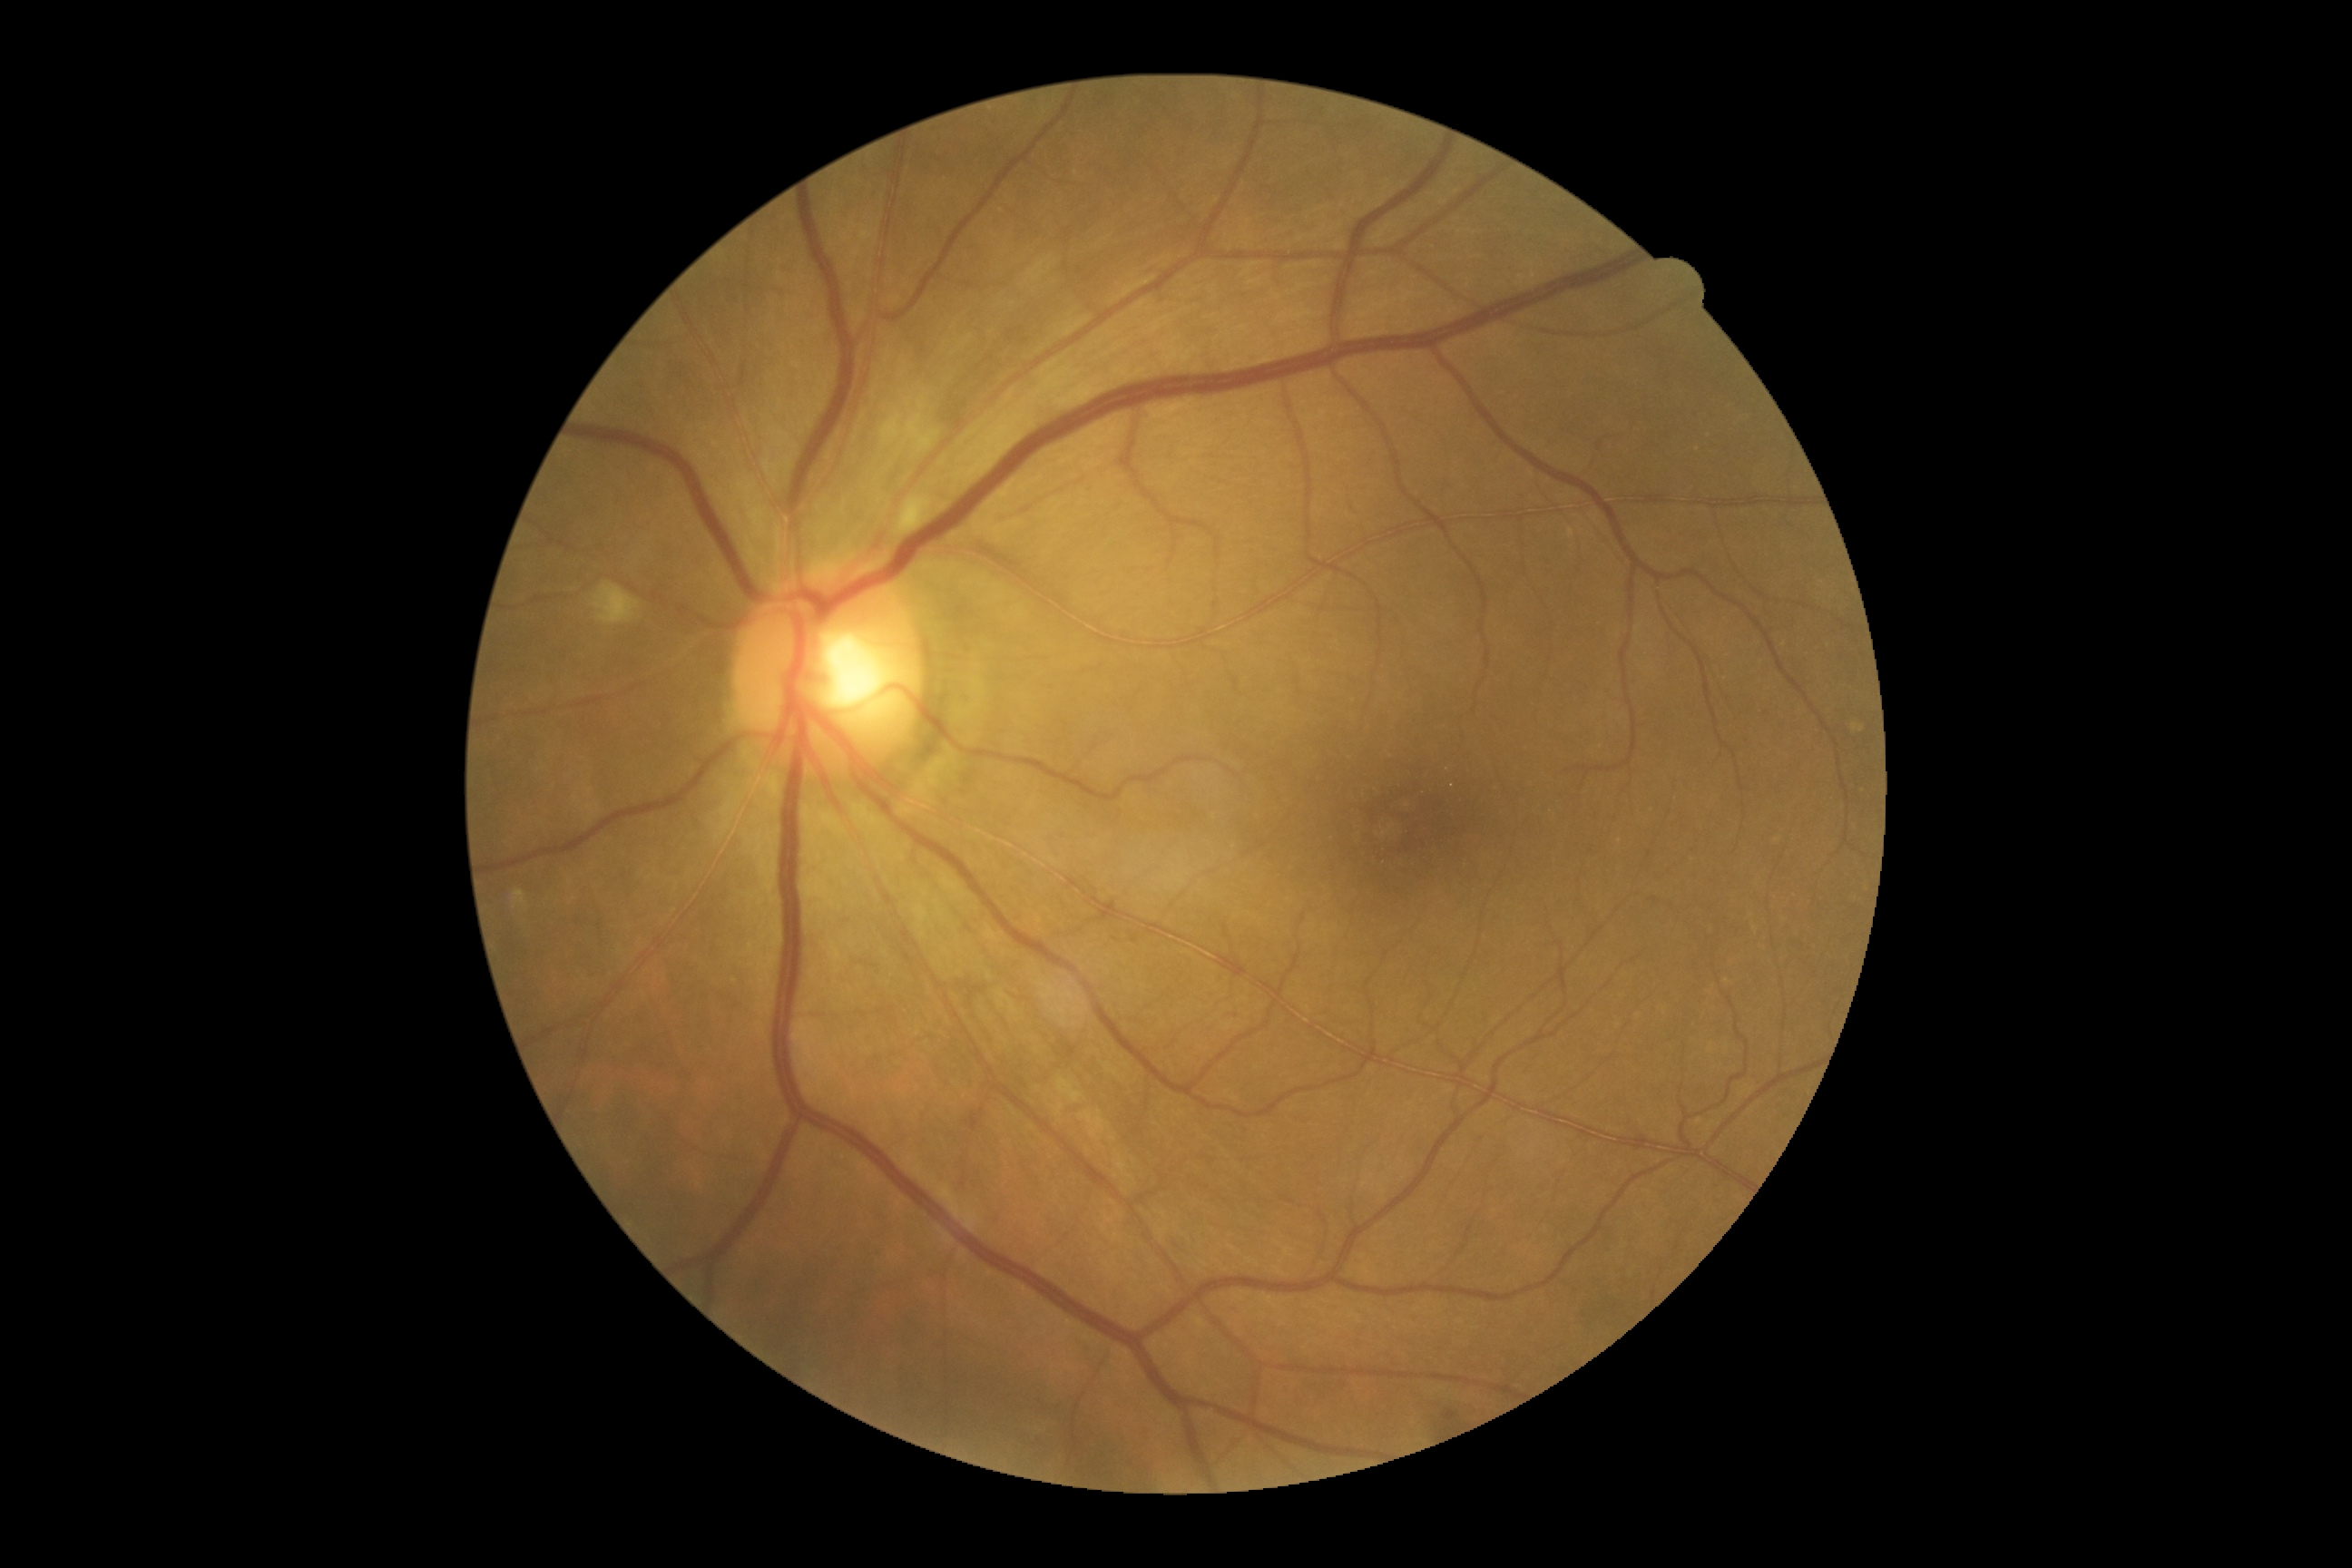

DR severity is grade 2 (moderate NPDR).